Acquired with a NIDEK AFC-230 · 848x848 · 45 degree fundus photograph · modified Davis grading · retinal fundus photograph — 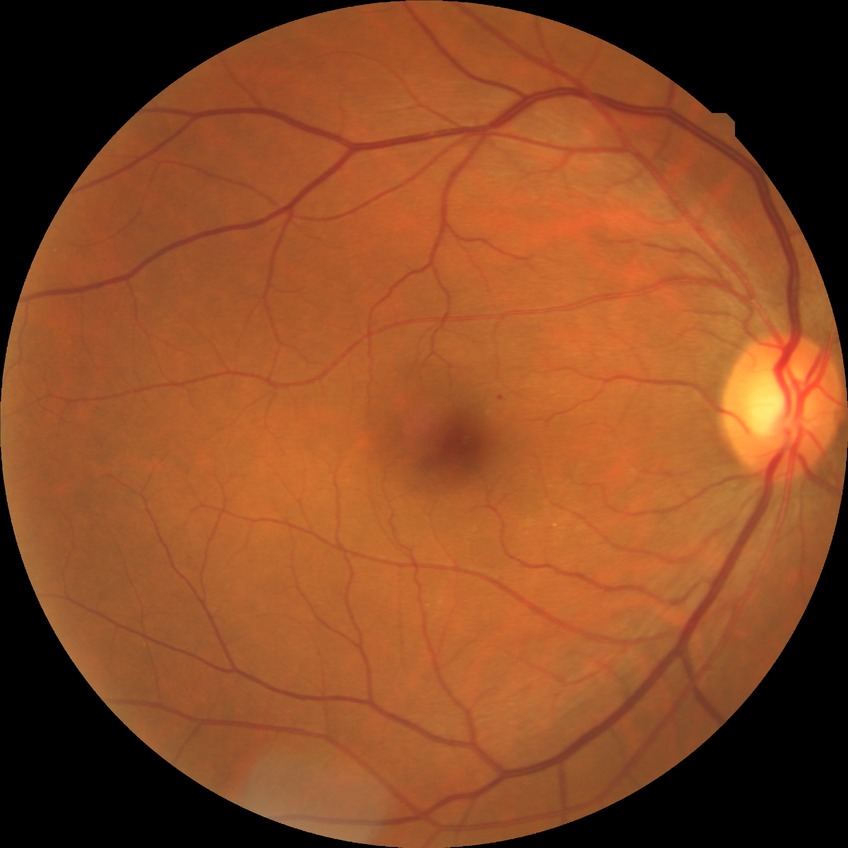   davis_grade: no diabetic retinopathy